Graded on the modified Davis scale. NIDEK AFC-230 fundus camera
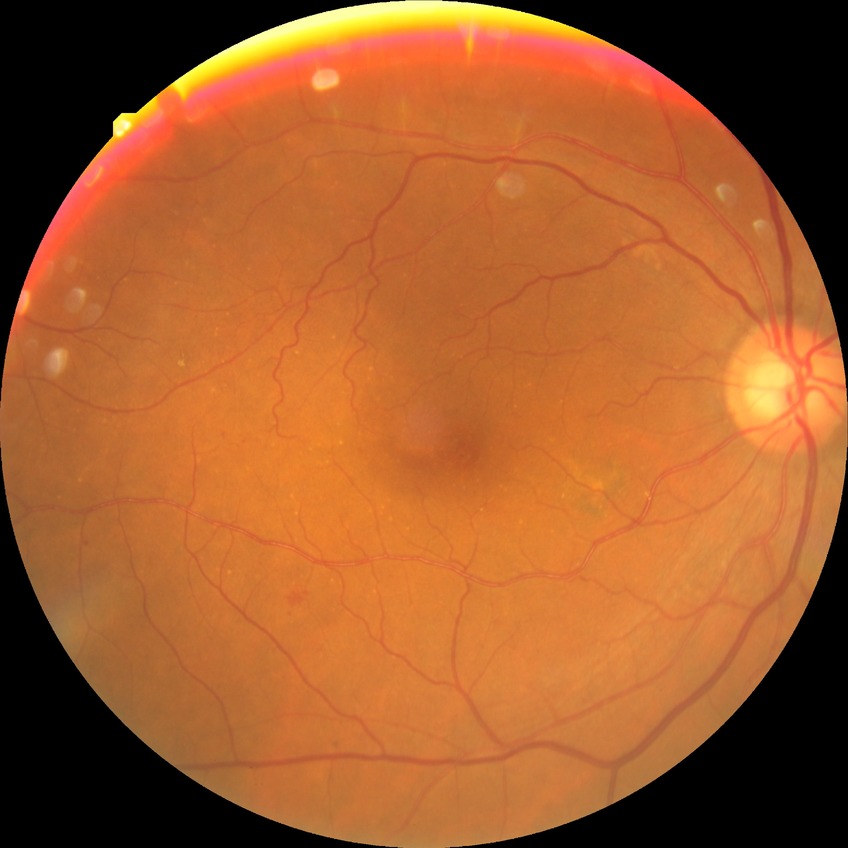 Diabetic retinopathy (DR) is no diabetic retinopathy (NDR).